Infant wide-field fundus photograph — 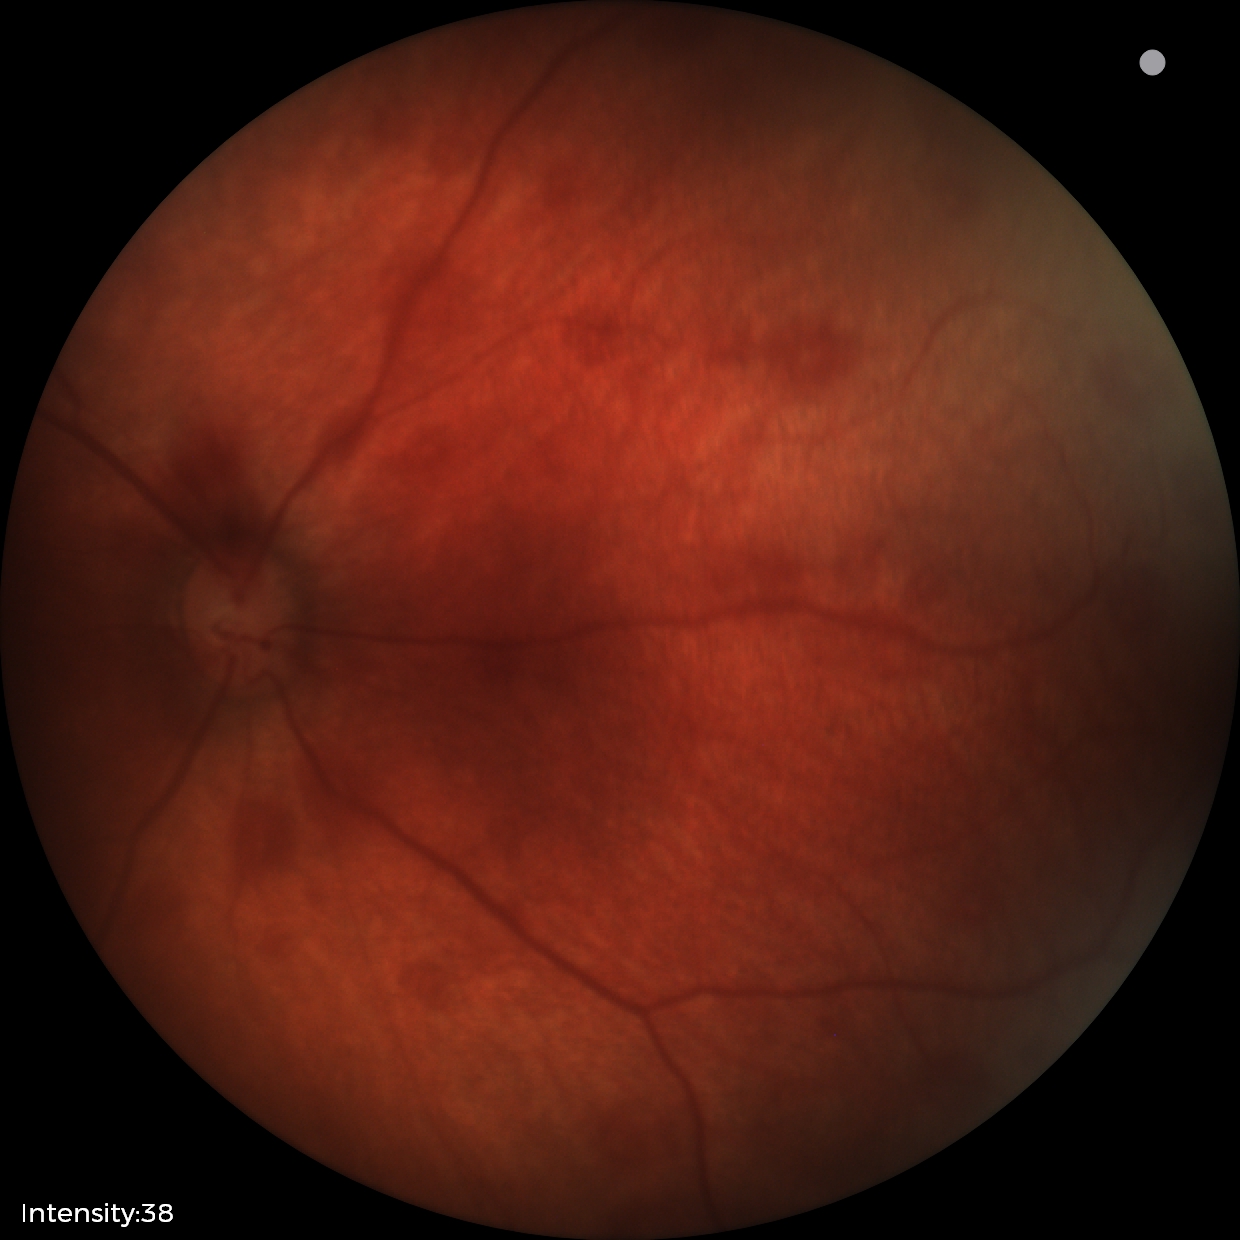

Screening examination consistent with retinal hemorrhages.